Image size 848x848. Posterior pole color fundus photograph. Camera: NIDEK AFC-230
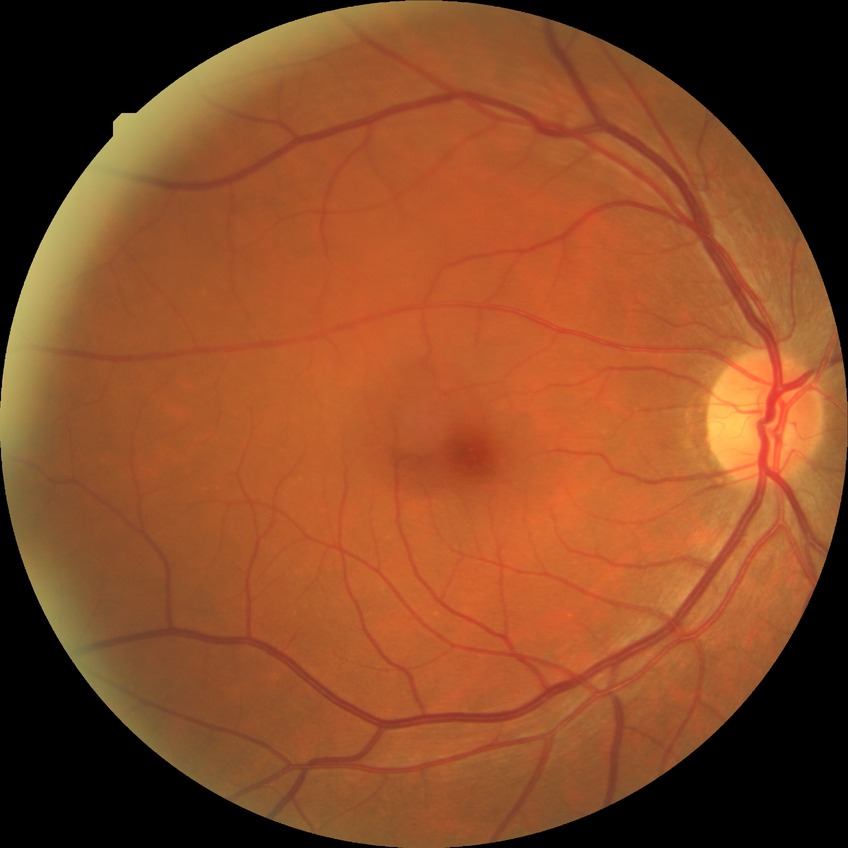 Retinopathy grade: no diabetic retinopathy.